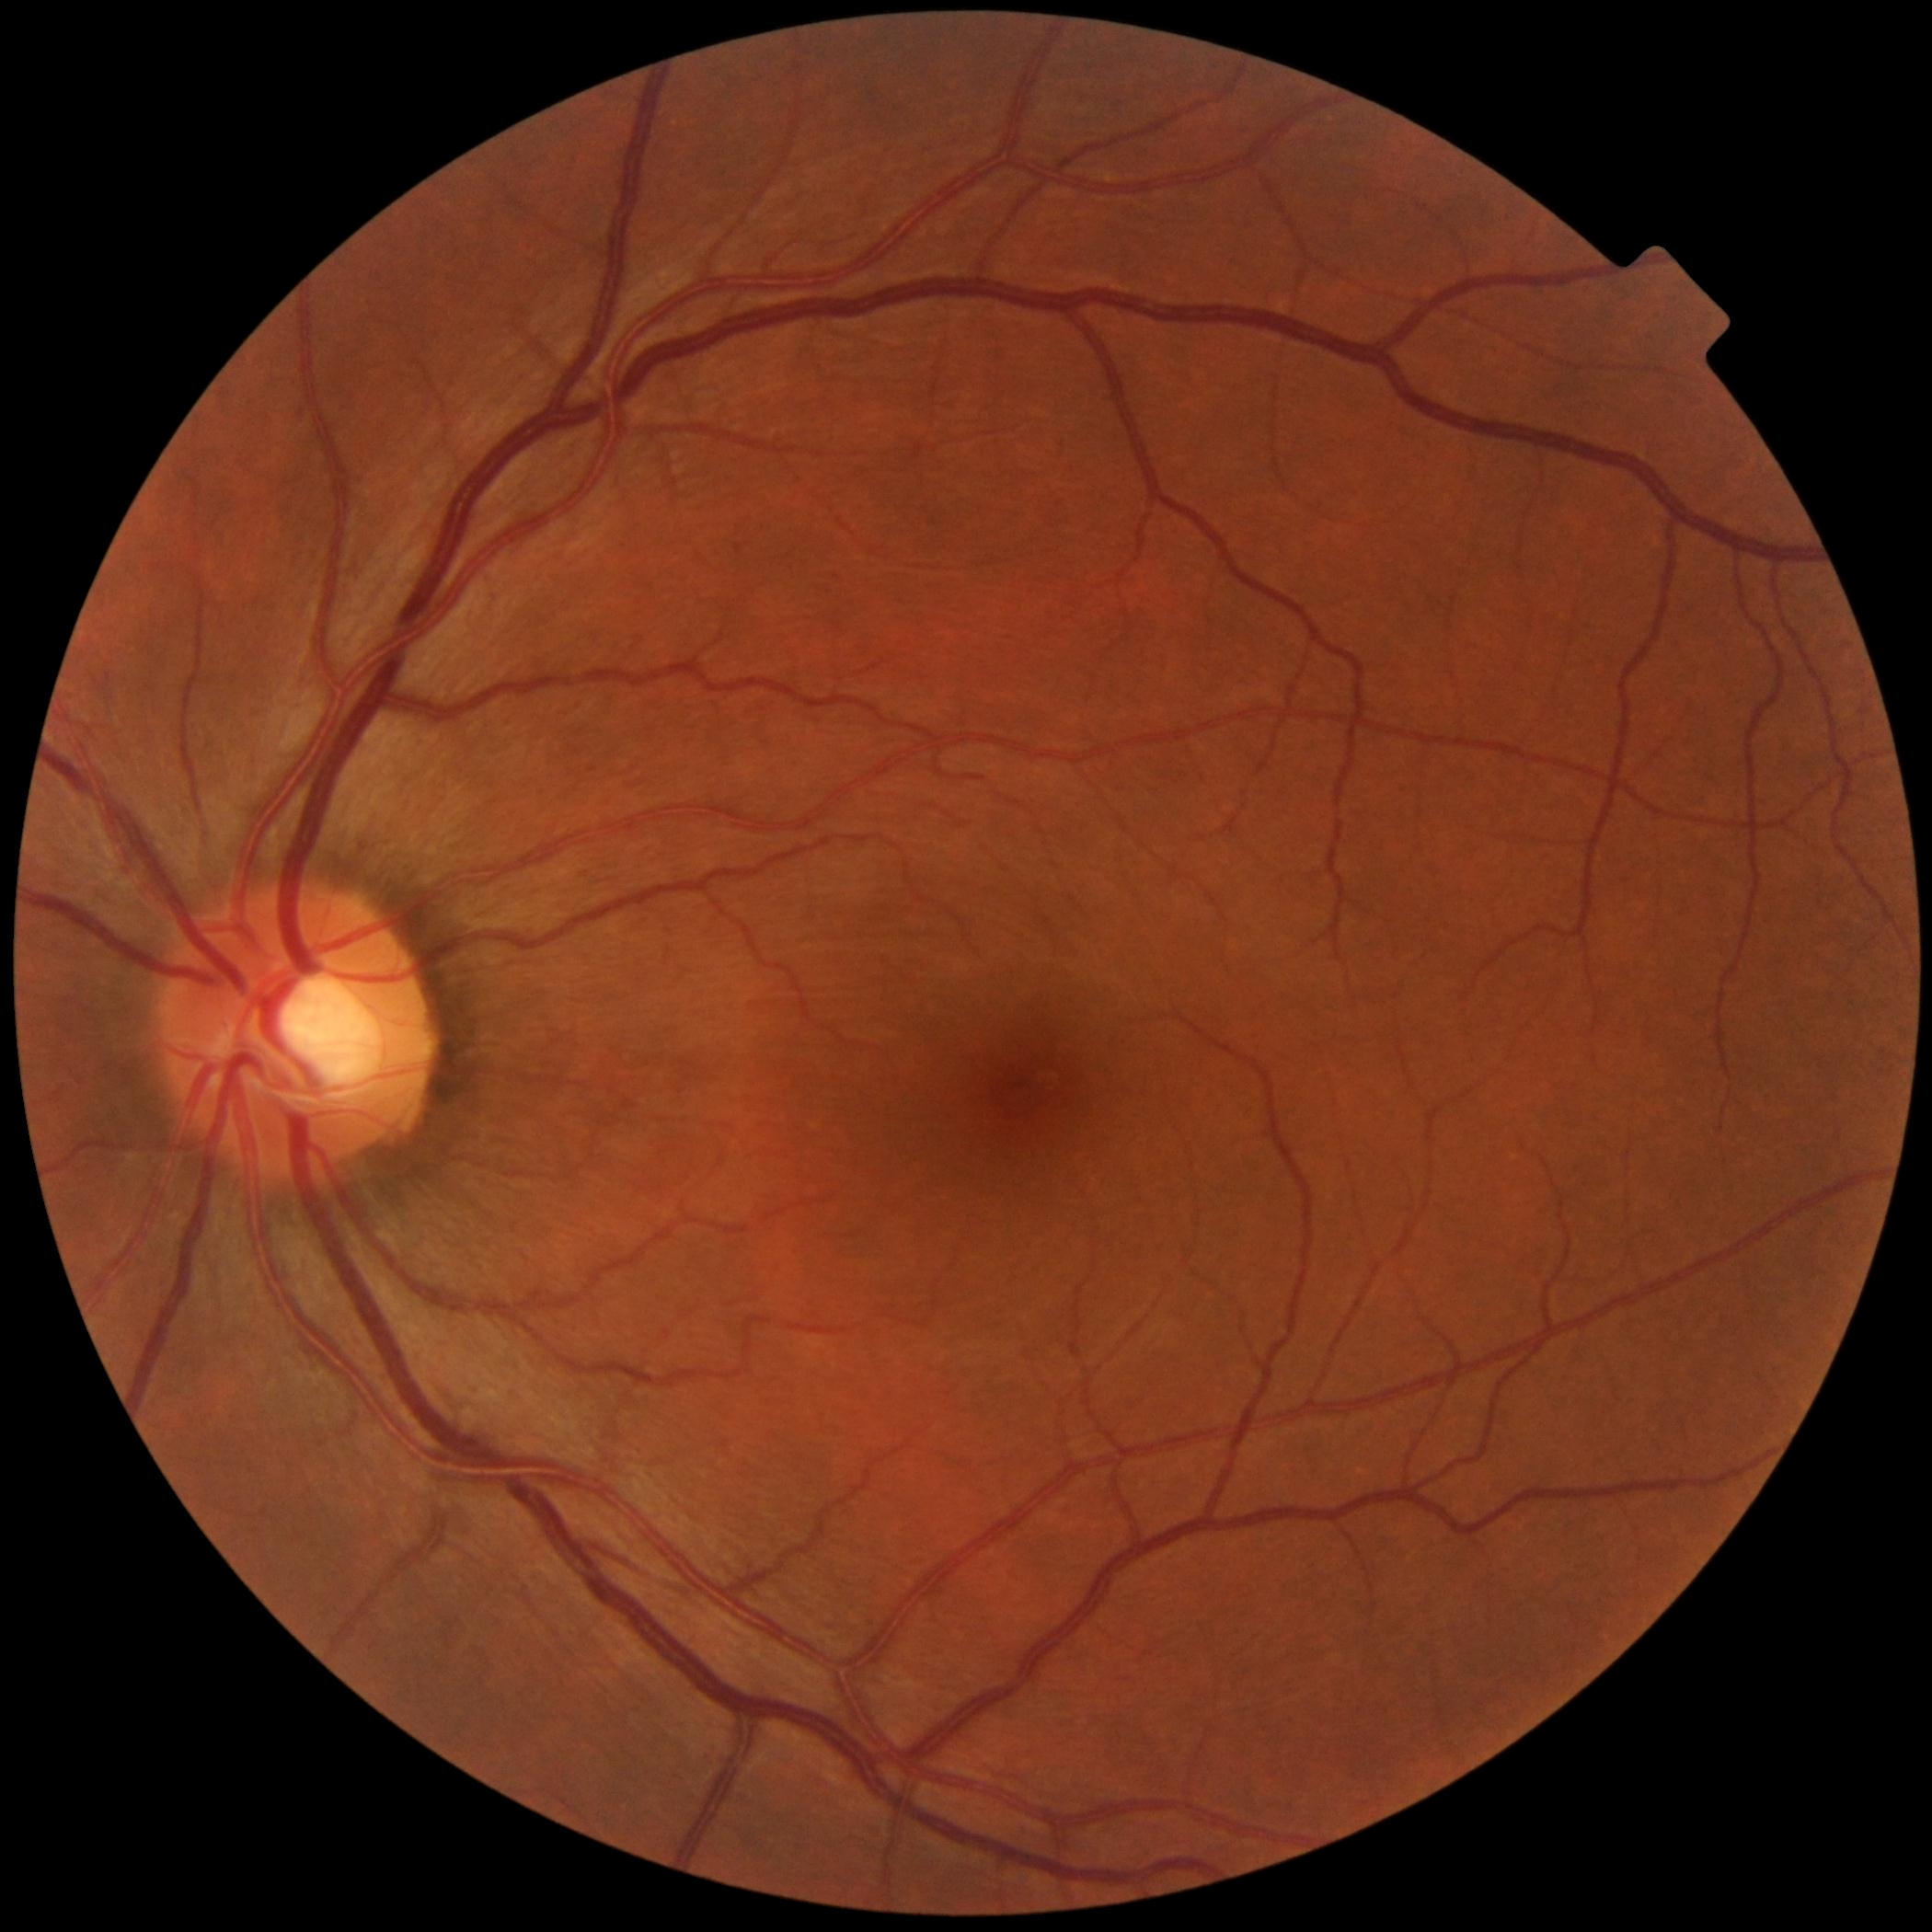 DR: no apparent diabetic retinopathy (grade 0).